Image size 2212x1659 · retinal fundus photograph.
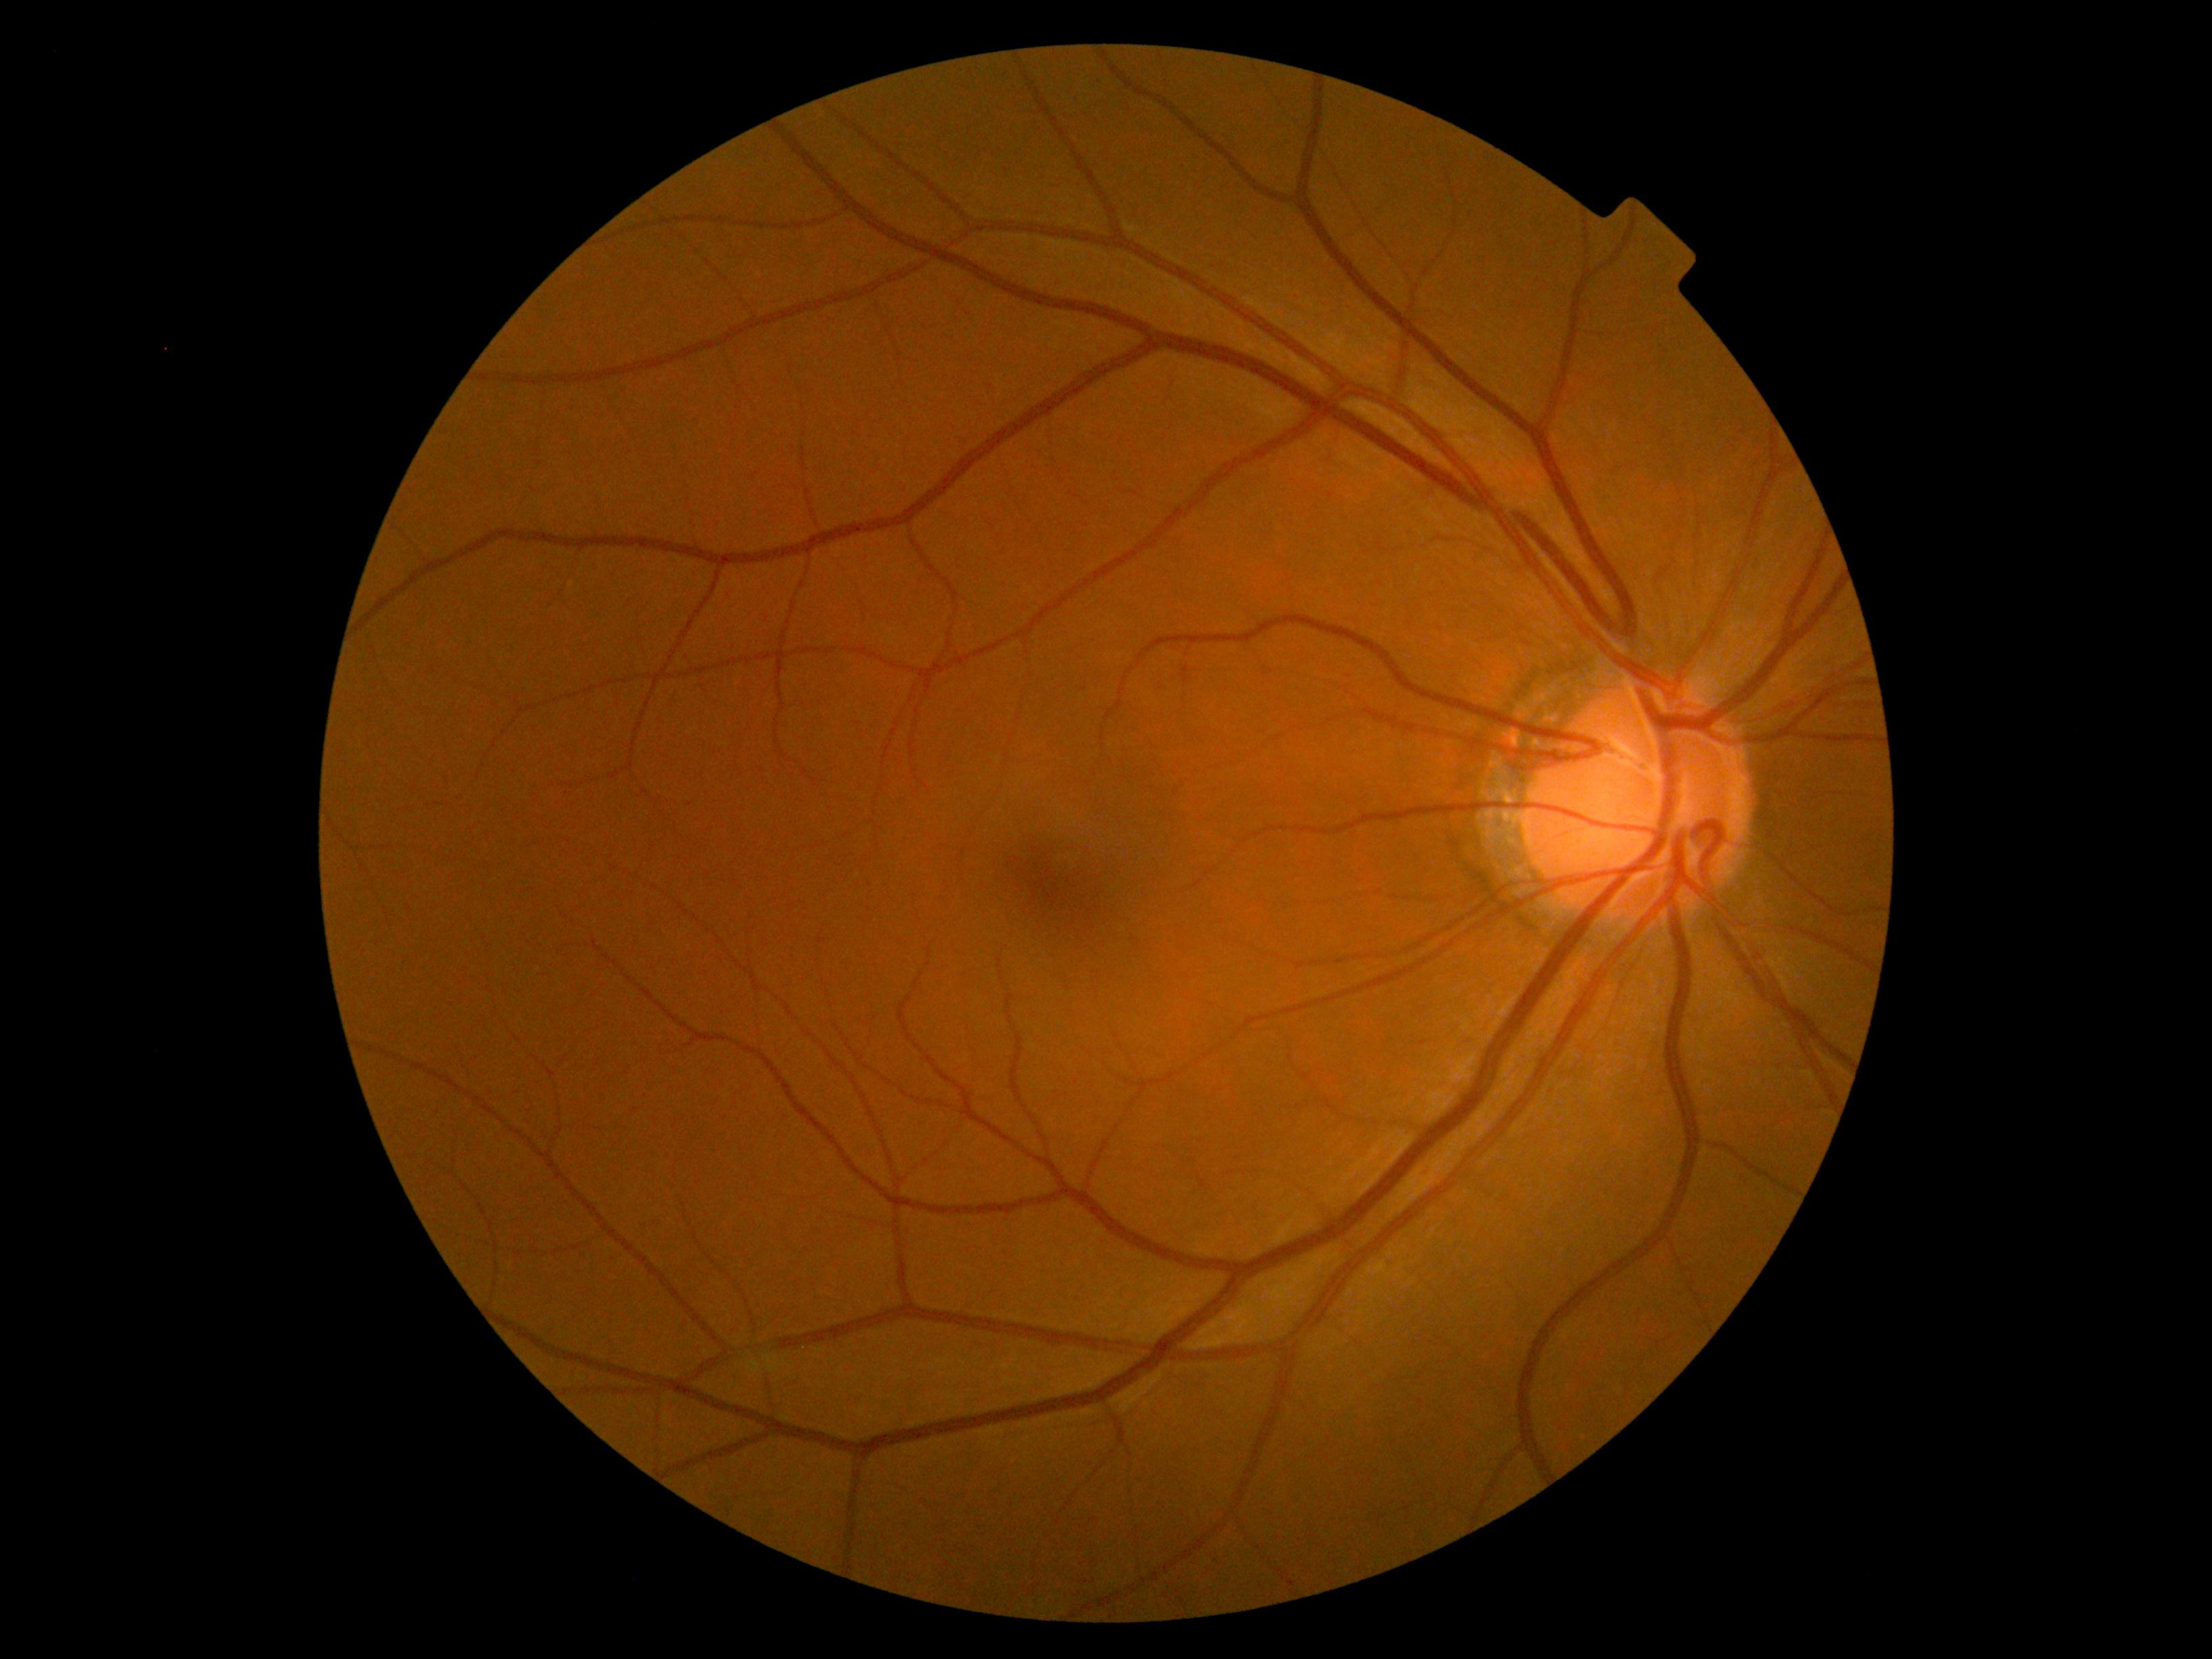

retinopathy grade@0.